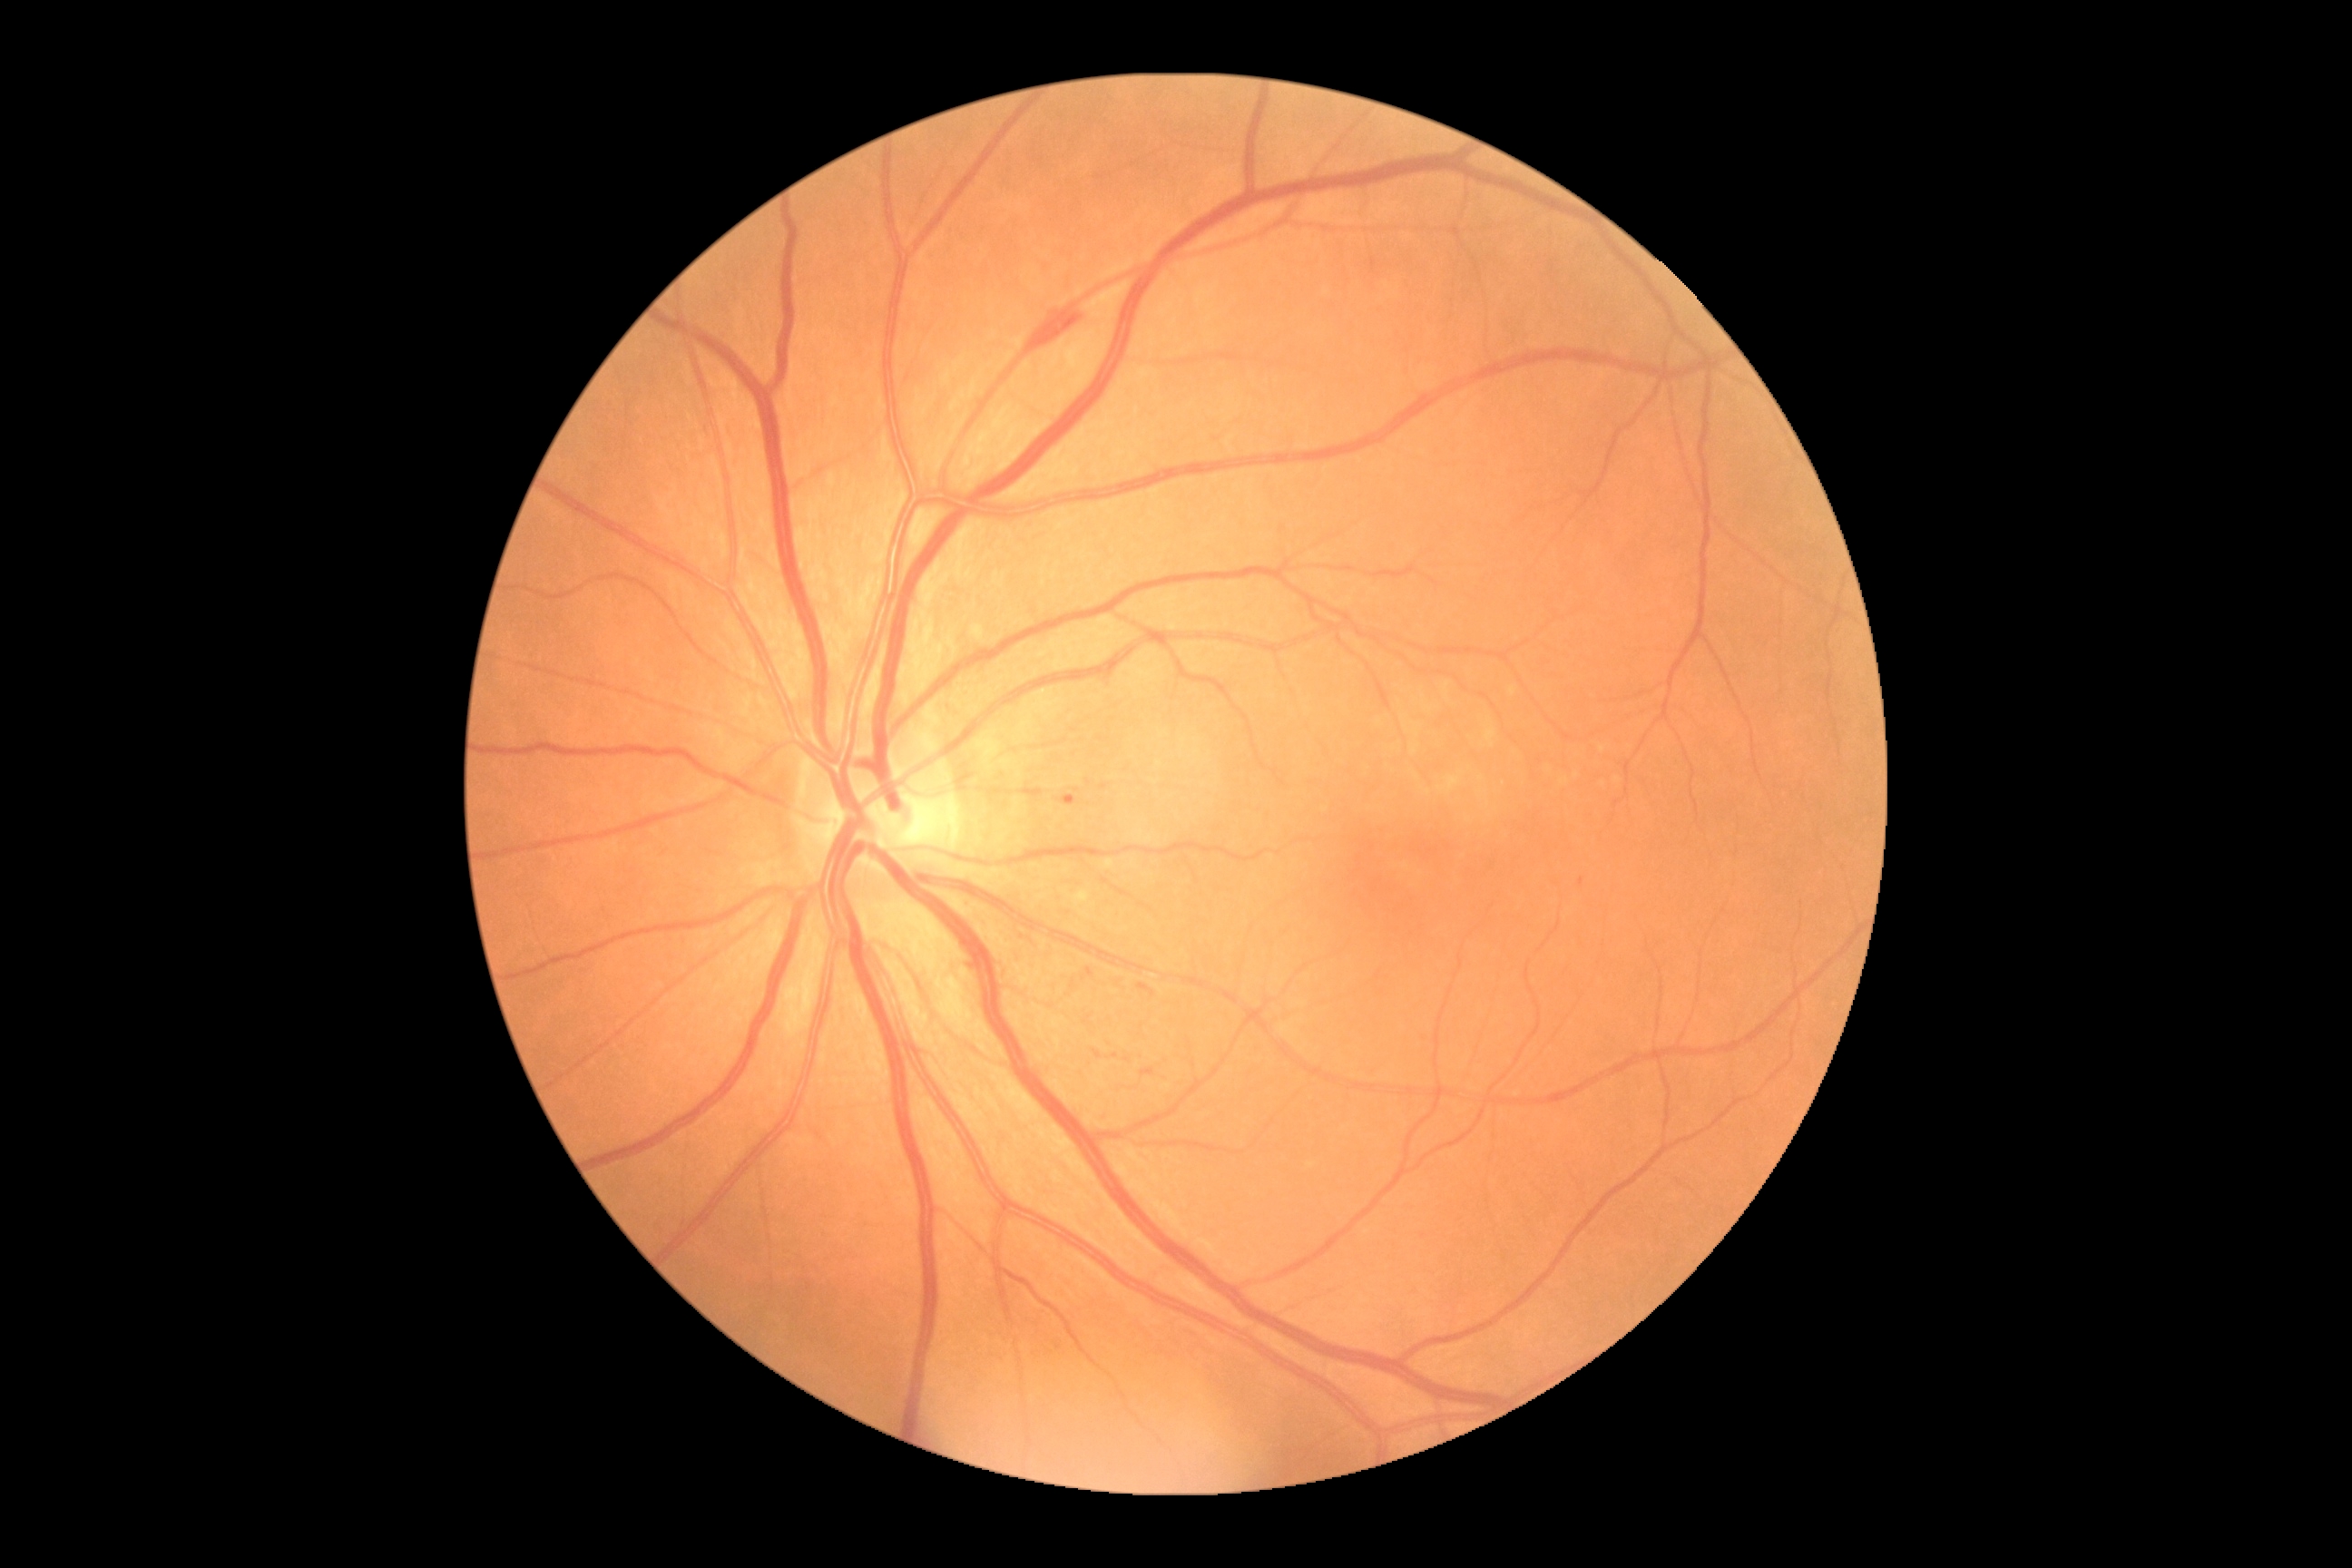 retinopathy: 2.